Color fundus image, camera: Remidio FOP fundus camera: 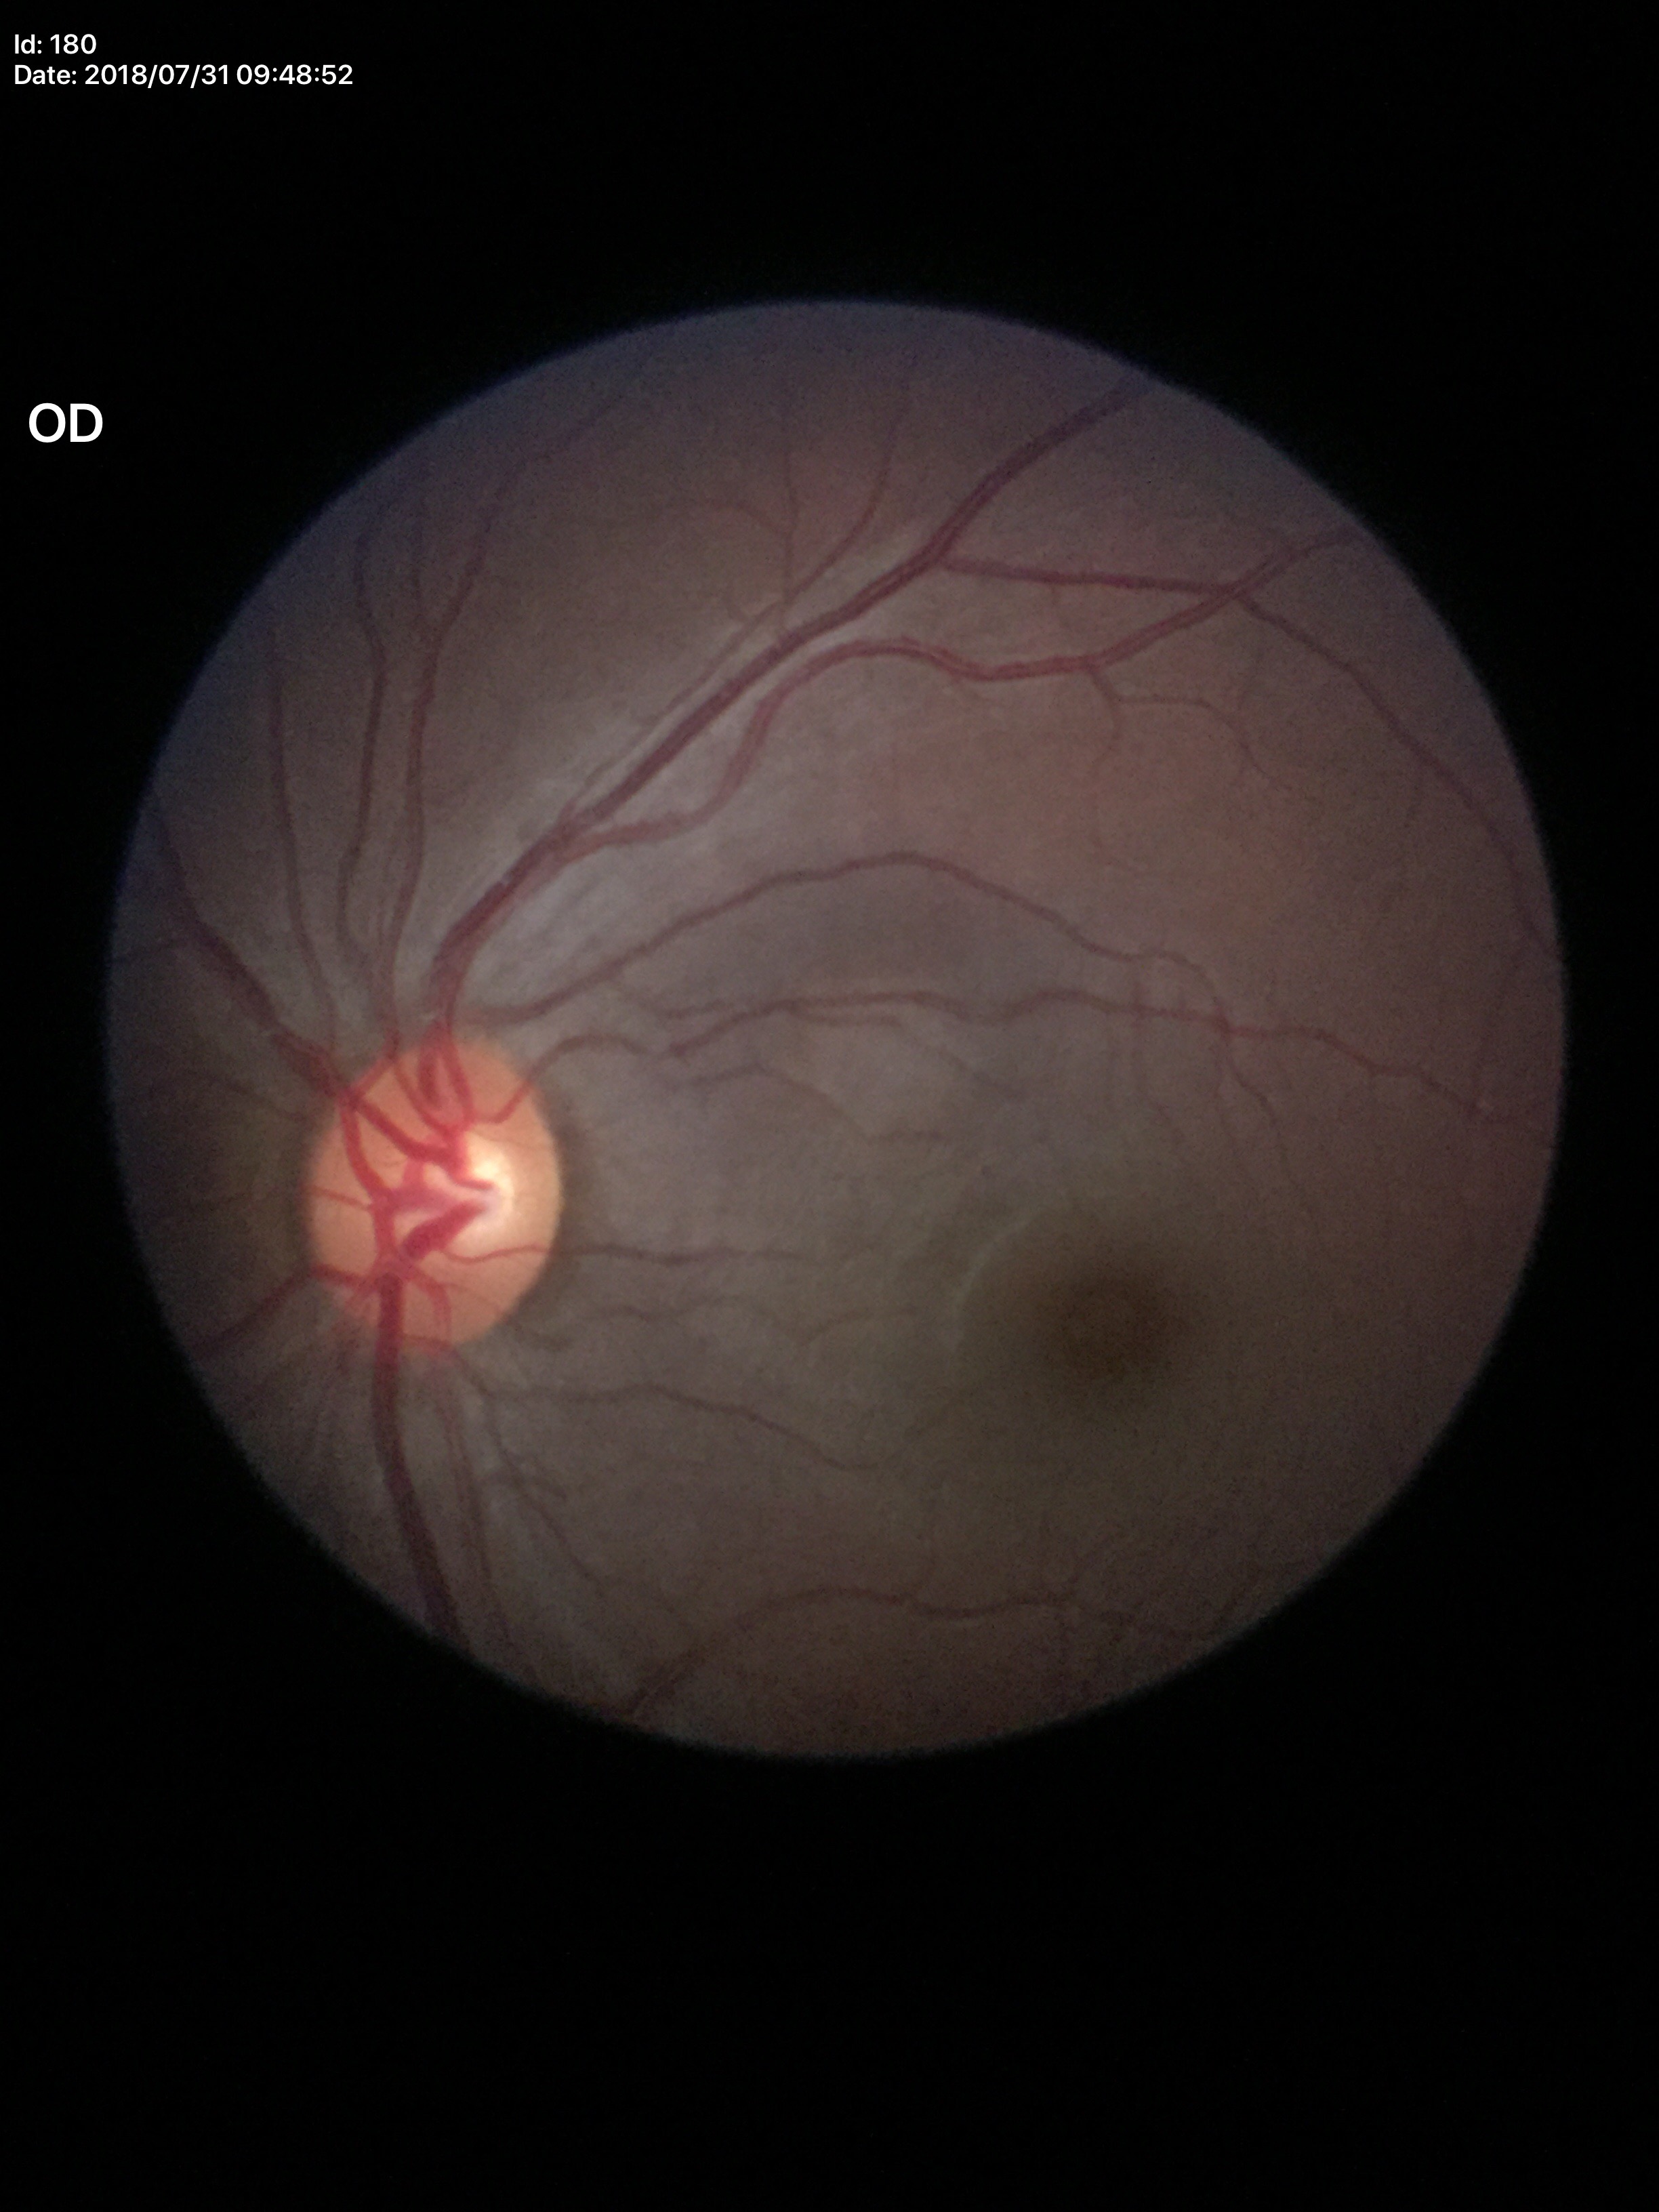

Not suspicious for glaucoma.
Vertical cup-to-disc ratio: 0.52.
Horizontal cup-to-disc ratio is 0.55.